Color fundus photograph, 45° FOV:
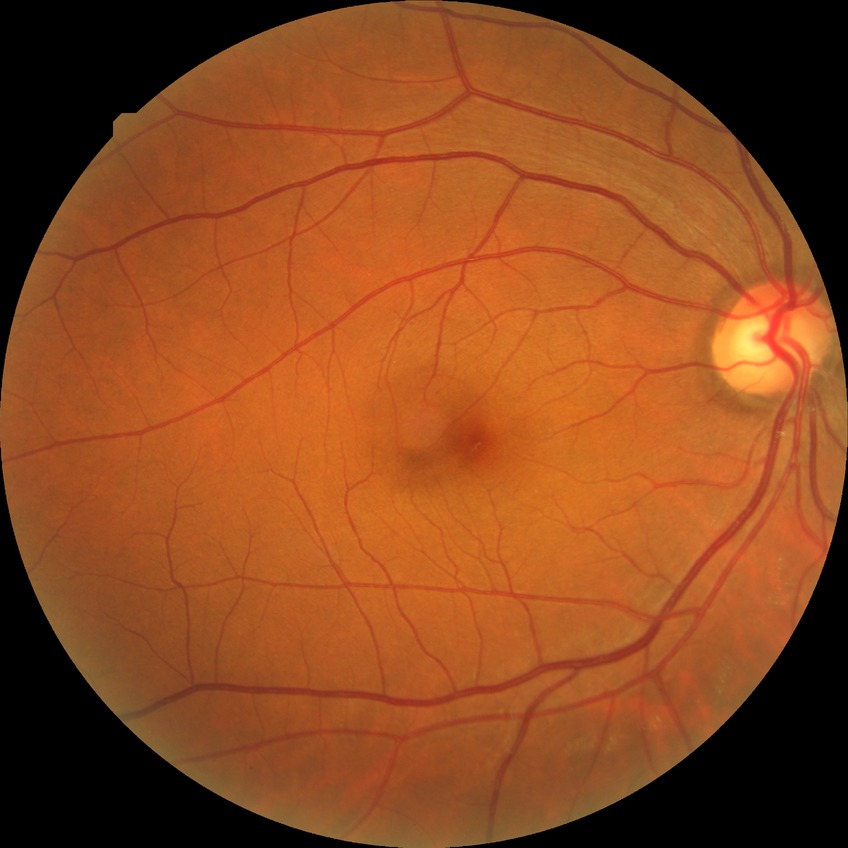

Davis grading: no diabetic retinopathy.